Graded on the modified Davis scale.
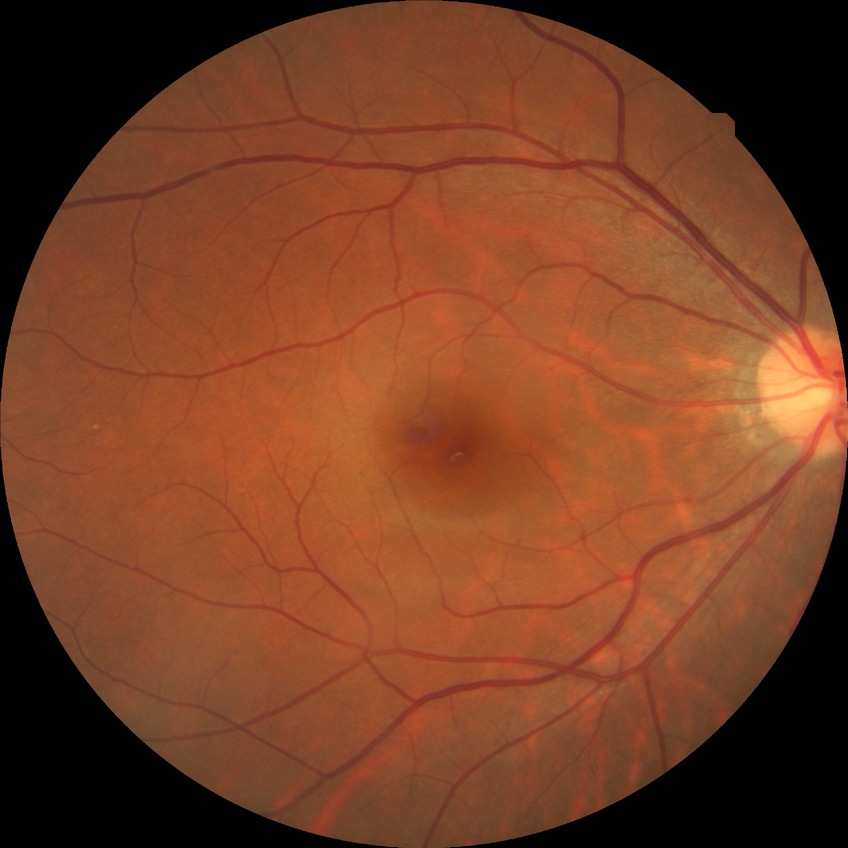
No diabetic retinal disease findings. Modified Davis grade is NDR.